45° field of view. 2144 x 1424 pixels:
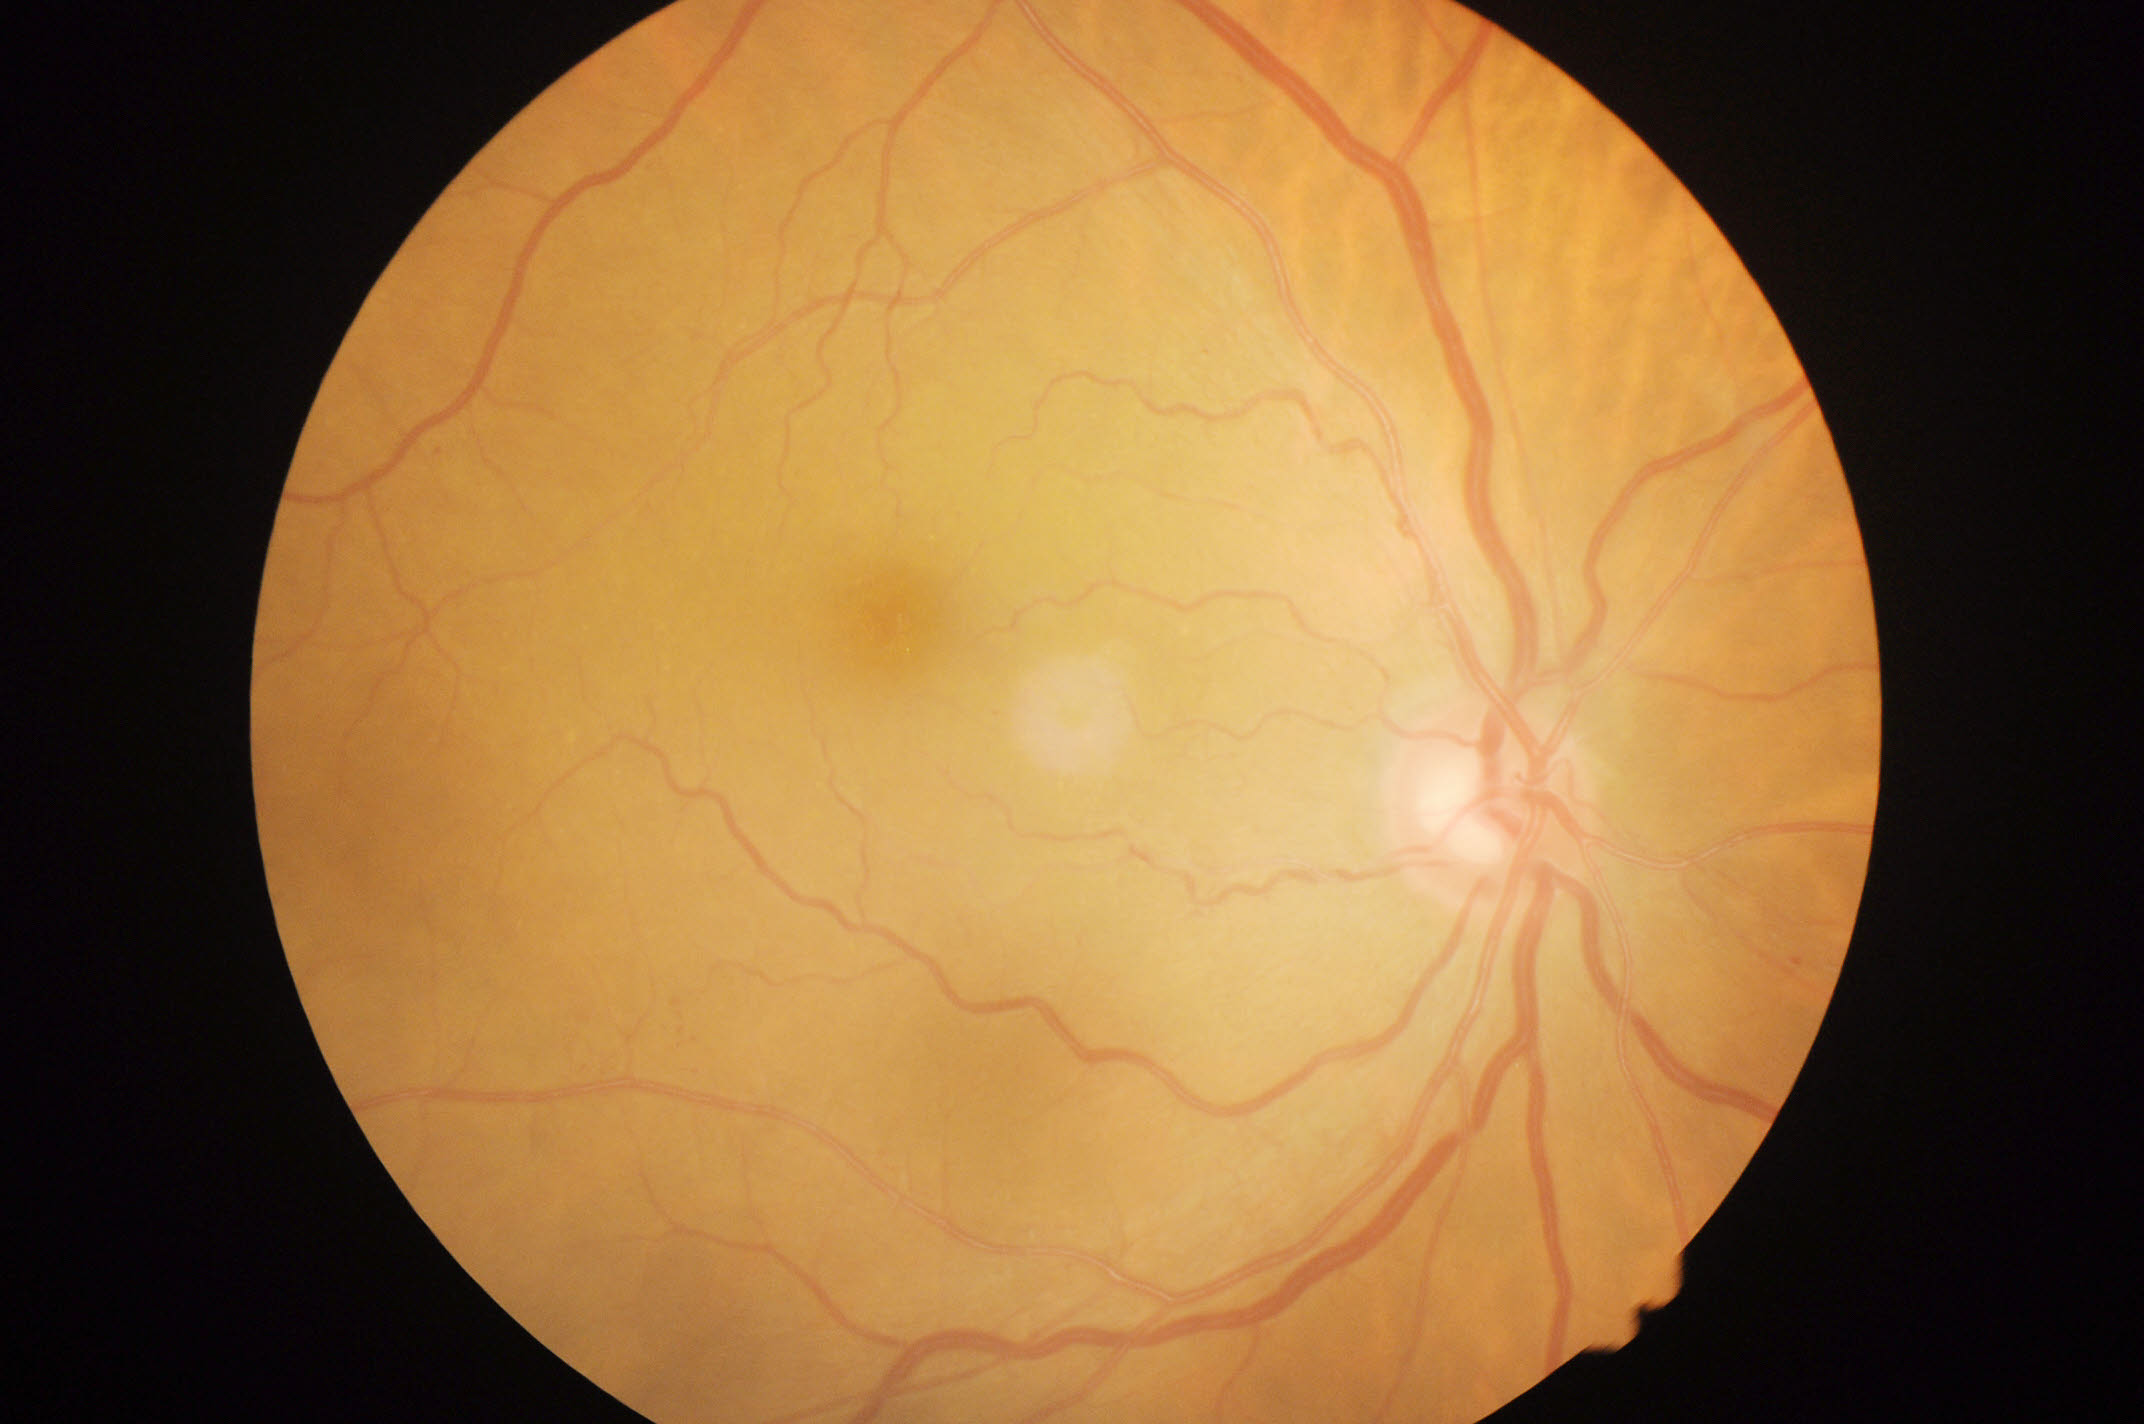
diabetic retinopathy (DR) = grade 1 (mild NPDR).